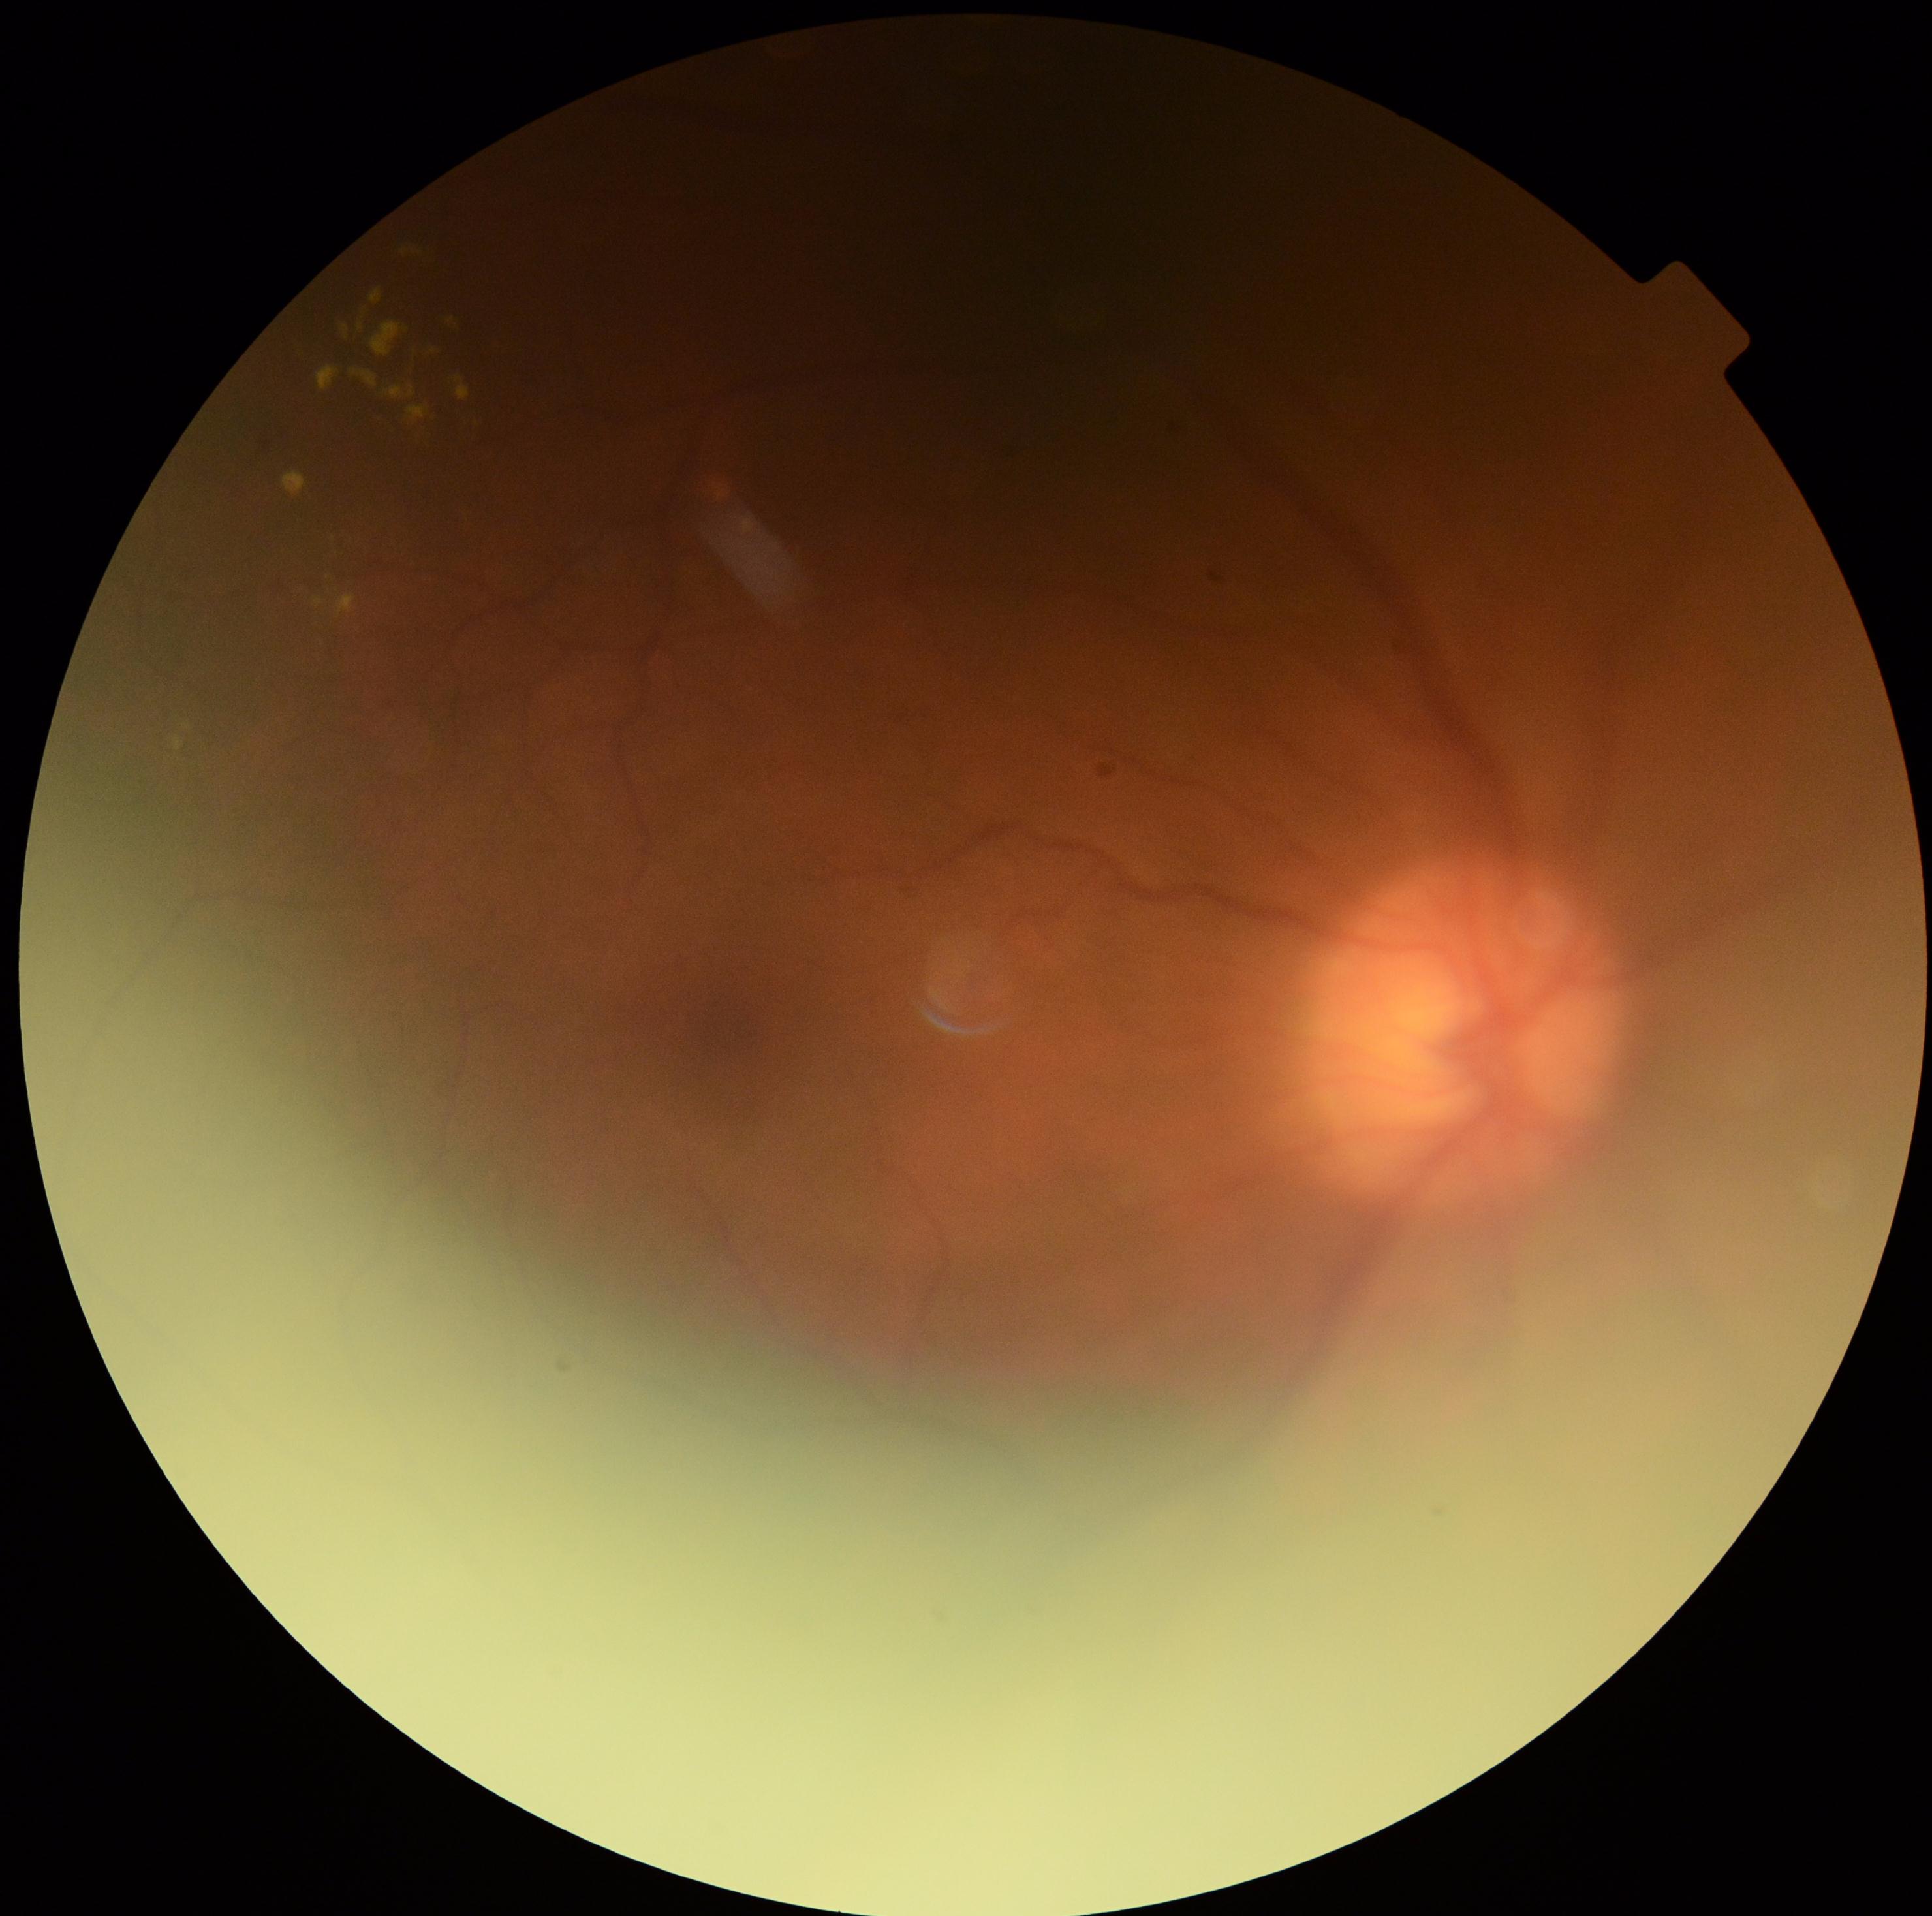
DR grade=2; DR class=non-proliferative diabetic retinopathy.